NIDEK AFC-230 fundus camera. Nonmydriatic — 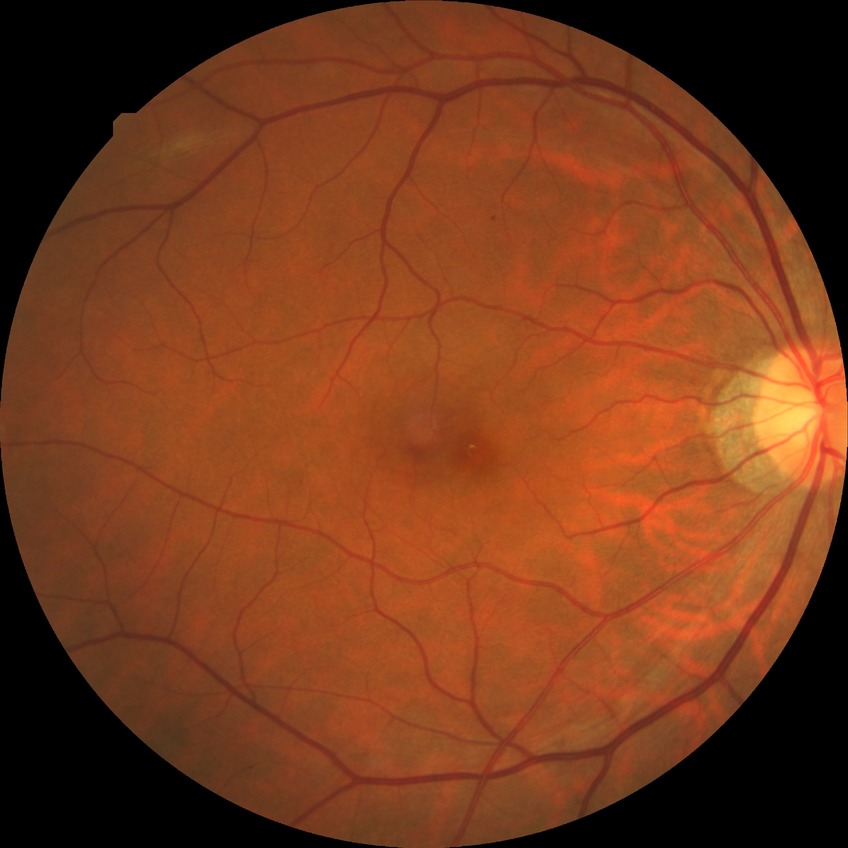
Diabetic retinopathy (DR) is SDR (simple diabetic retinopathy).